Color fundus photograph:
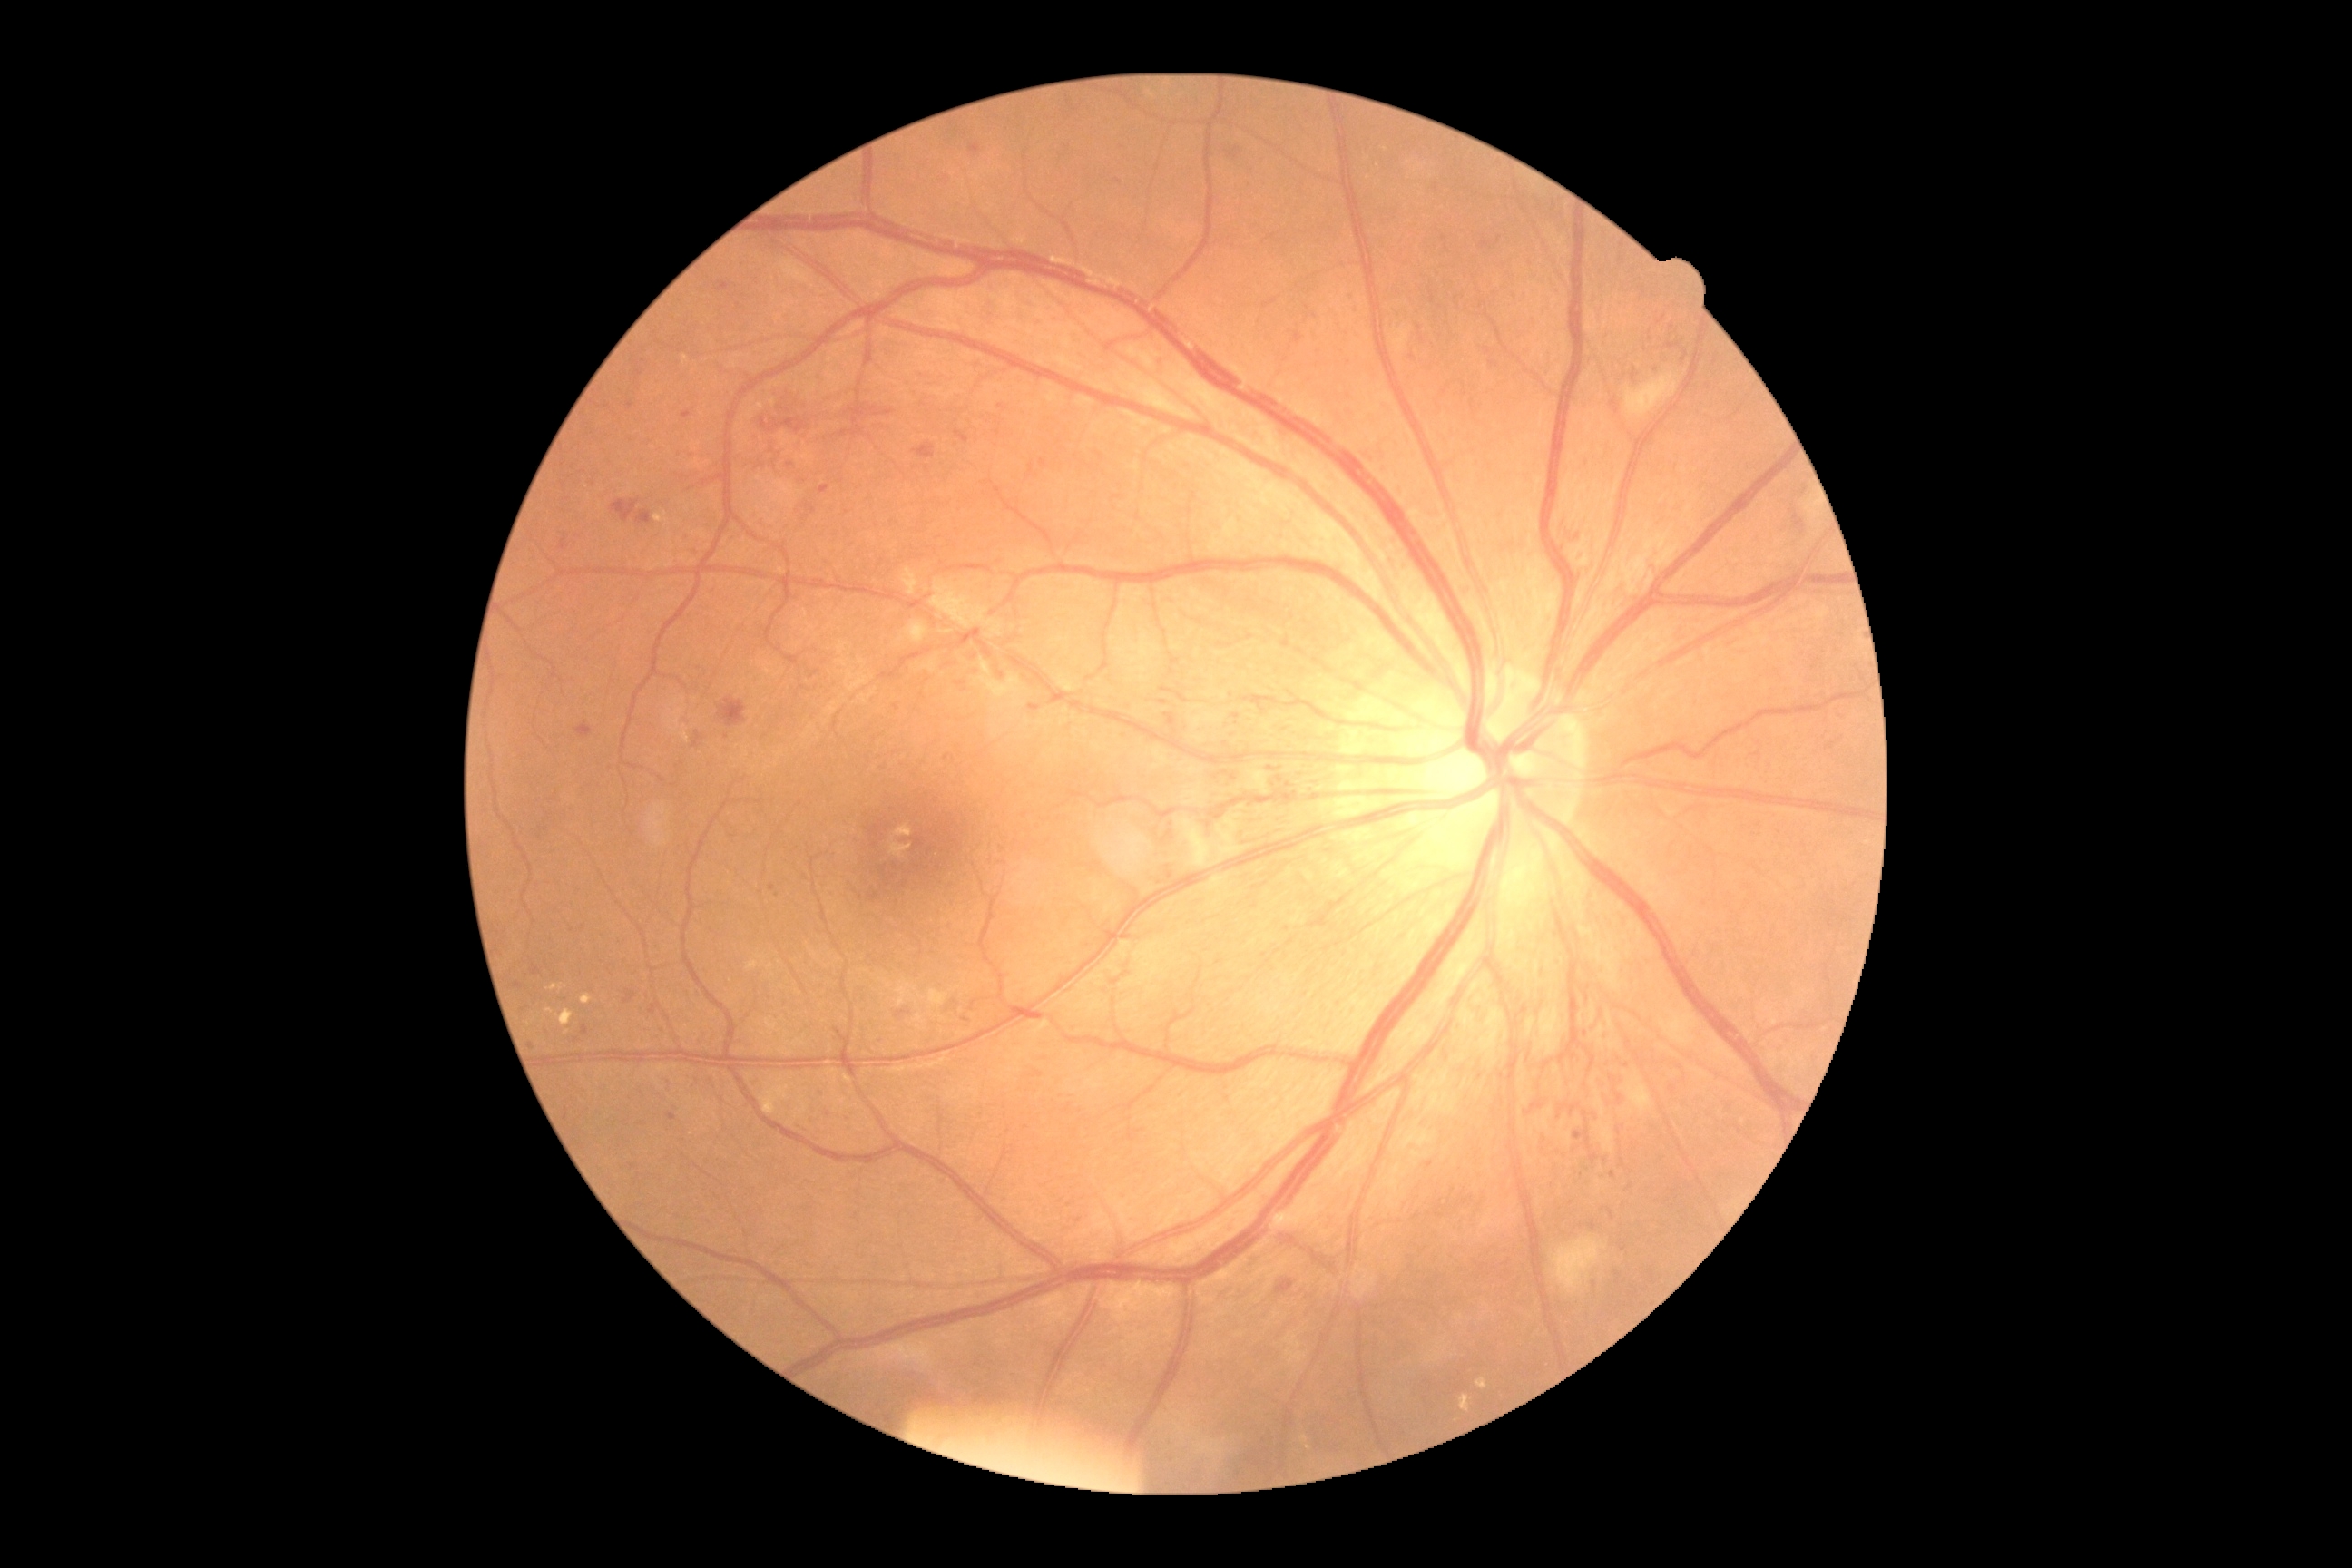

<lesions partial="true">
  <dr_grade>3</dr_grade>
  <he partial="true">{"left": 576, "top": 723, "right": 593, "bottom": 738}; {"left": 1632, "top": 369, "right": 1638, "bottom": 380}; {"left": 1228, "top": 148, "right": 1240, "bottom": 157}; {"left": 623, "top": 990, "right": 636, "bottom": 1004}; {"left": 819, "top": 485, "right": 830, "bottom": 495}; {"left": 1594, "top": 1113, "right": 1598, "bottom": 1124}; {"left": 667, "top": 1113, "right": 676, "bottom": 1121}; {"left": 912, "top": 444, "right": 936, "bottom": 460}; {"left": 760, "top": 418, "right": 808, "bottom": 433}; {"left": 531, "top": 965, "right": 542, "bottom": 975}; {"left": 1489, "top": 362, "right": 1498, "bottom": 368}; {"left": 1602, "top": 1155, "right": 1611, "bottom": 1173}</he>
  <he_small_approx>(x=896, y=707); (x=966, y=1020)</he_small_approx>
  <ma partial="true">{"left": 770, "top": 885, "right": 778, "bottom": 897}; {"left": 514, "top": 983, "right": 524, "bottom": 990}; {"left": 718, "top": 282, "right": 730, "bottom": 291}</ma>
  <ma_small_approx>(x=861, y=897); (x=1430, y=1165); (x=532, y=1046); (x=998, y=432); (x=835, y=852); (x=1118, y=181); (x=689, y=533); (x=1627, y=1066); (x=790, y=465); (x=630, y=405); (x=611, y=767); (x=1424, y=340); (x=879, y=1042); (x=1579, y=1176)</ma_small_approx>
</lesions>